2352x1568: 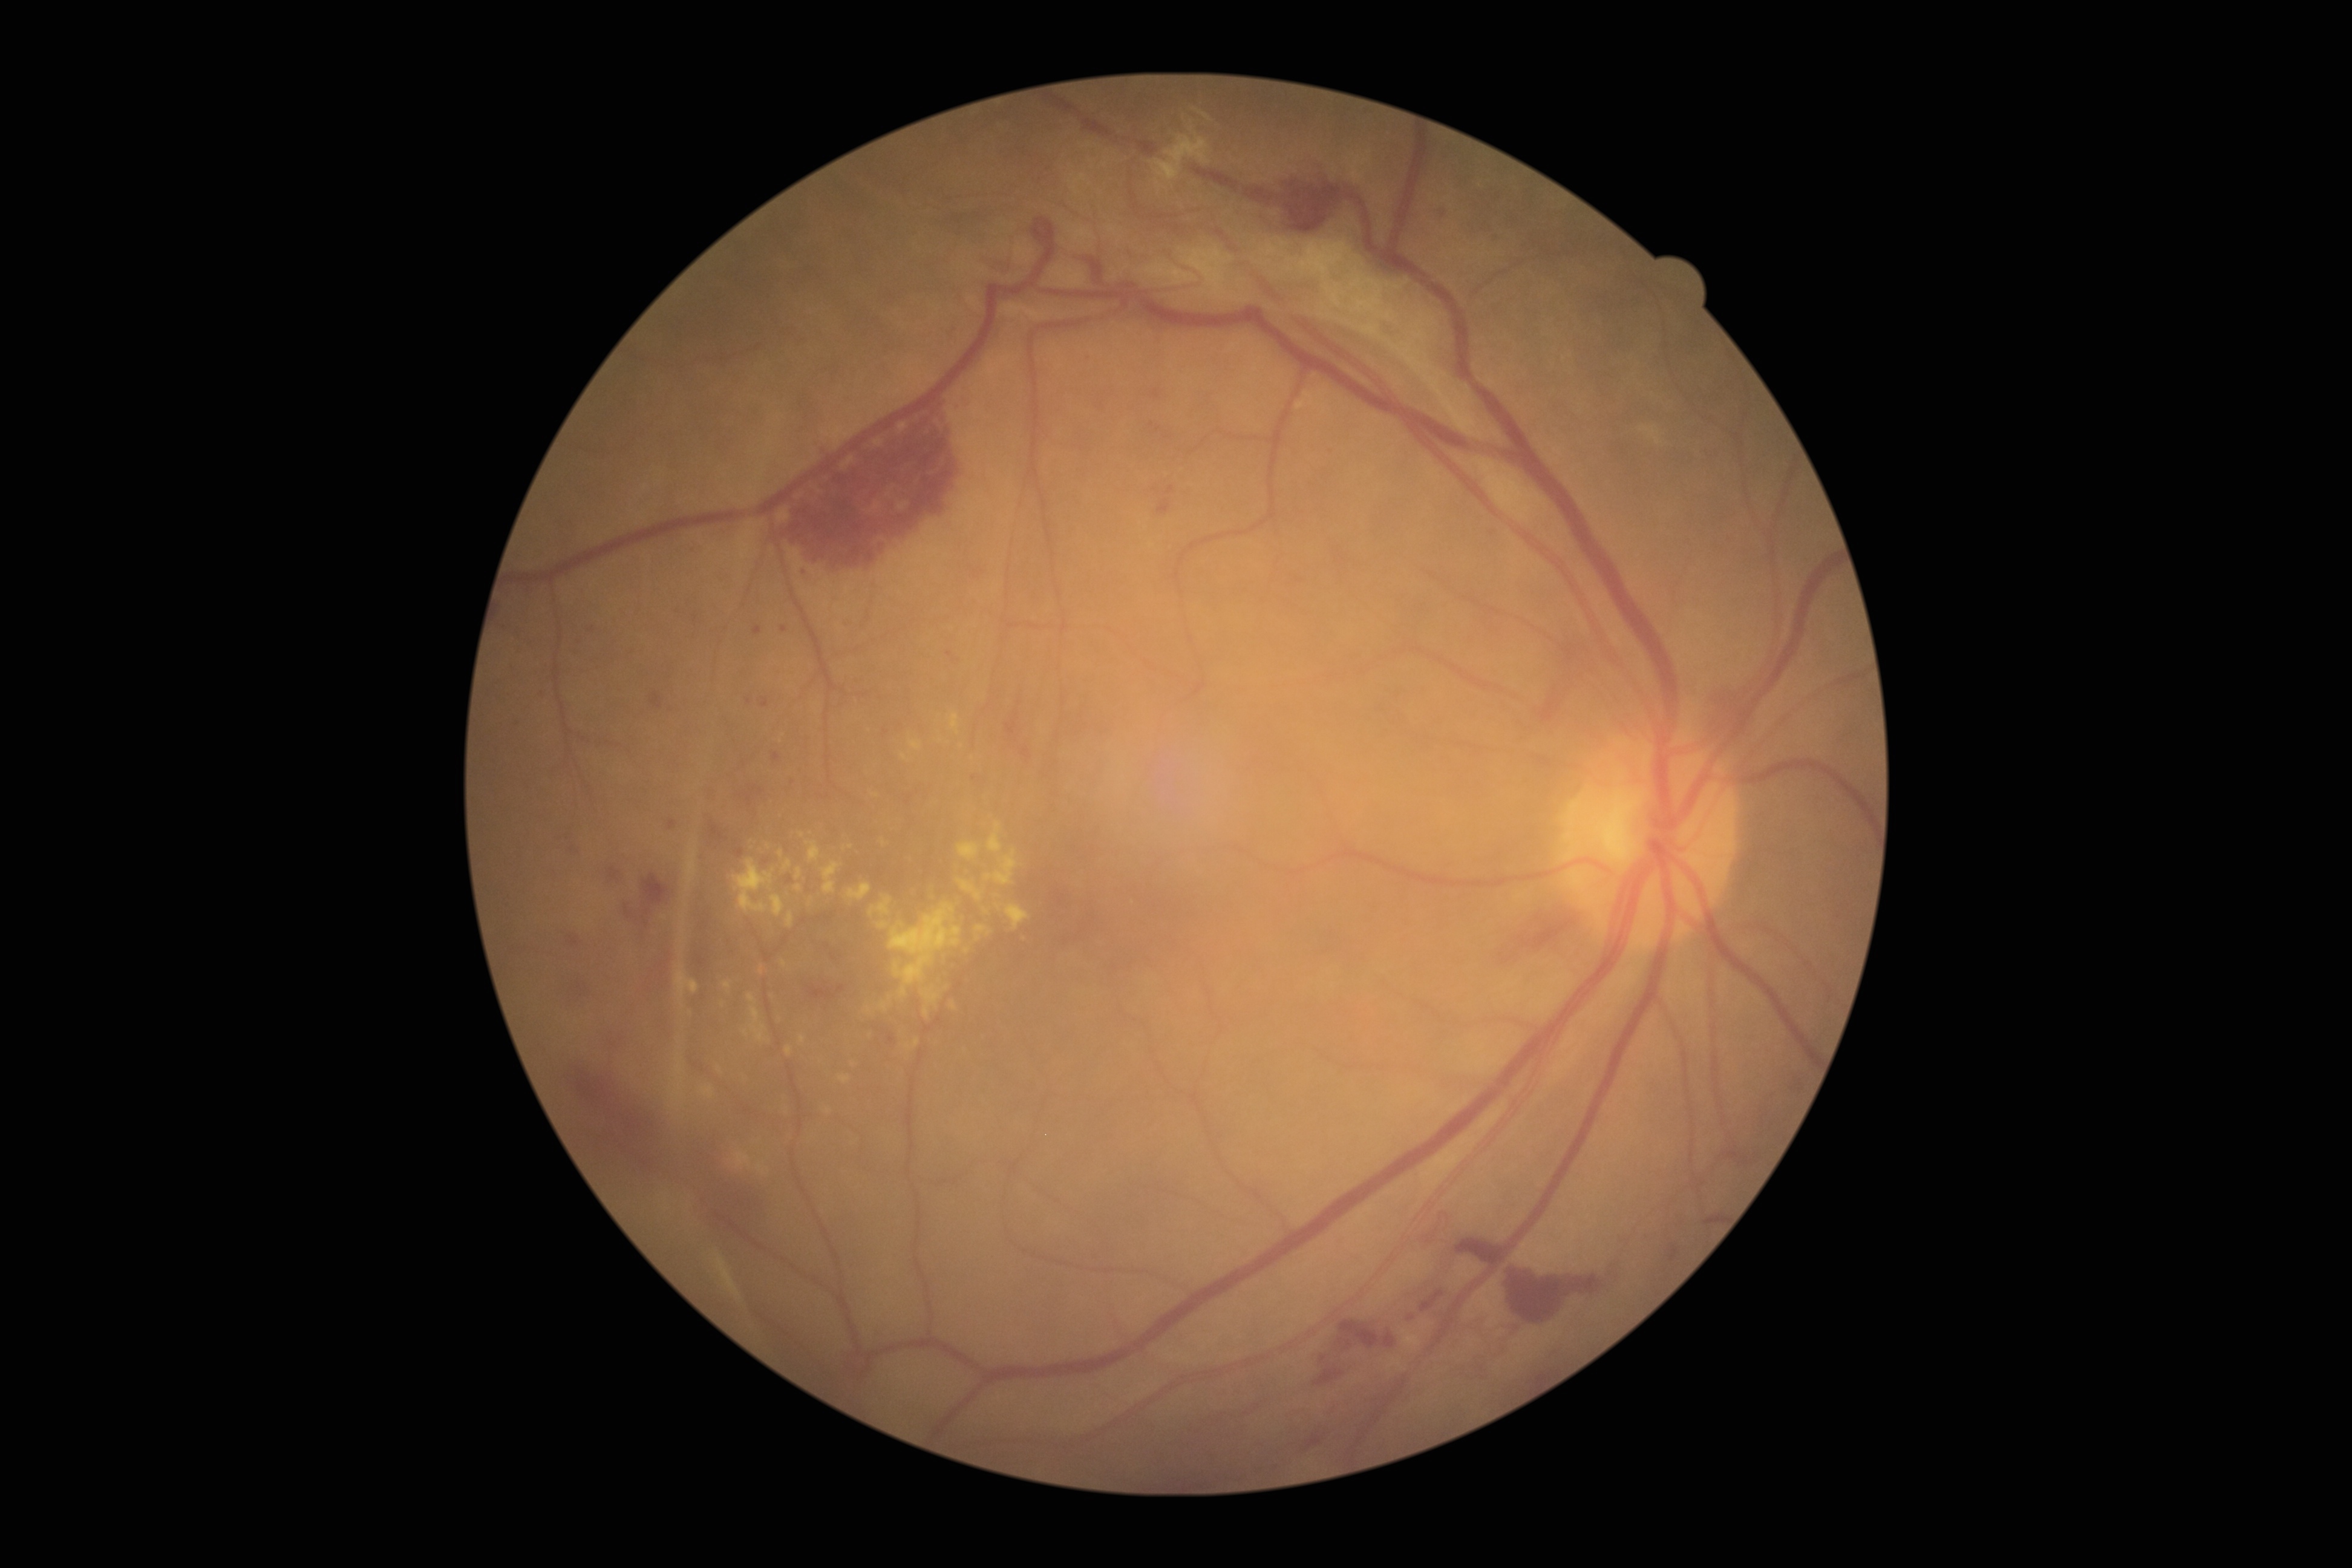 Diabetic retinopathy grade is 4 (PDR) — neovascularization and/or vitreous/pre-retinal hemorrhage. Hard exudates include those at [735,1152,752,1169]; [800,1036,806,1044]; [1005,903,1030,930]; [987,822,1002,854]; [783,861,792,871]; [838,1075,851,1085]; [958,843,982,861]; [797,867,802,880]; [758,1162,770,1177]; [881,839,889,848]; [985,849,1018,885]; [950,1001,958,1011]. Additional small hard exudates near Point(802, 835); Point(876, 795); Point(967, 950); Point(781, 853).